Remidio Fundus on Phone: 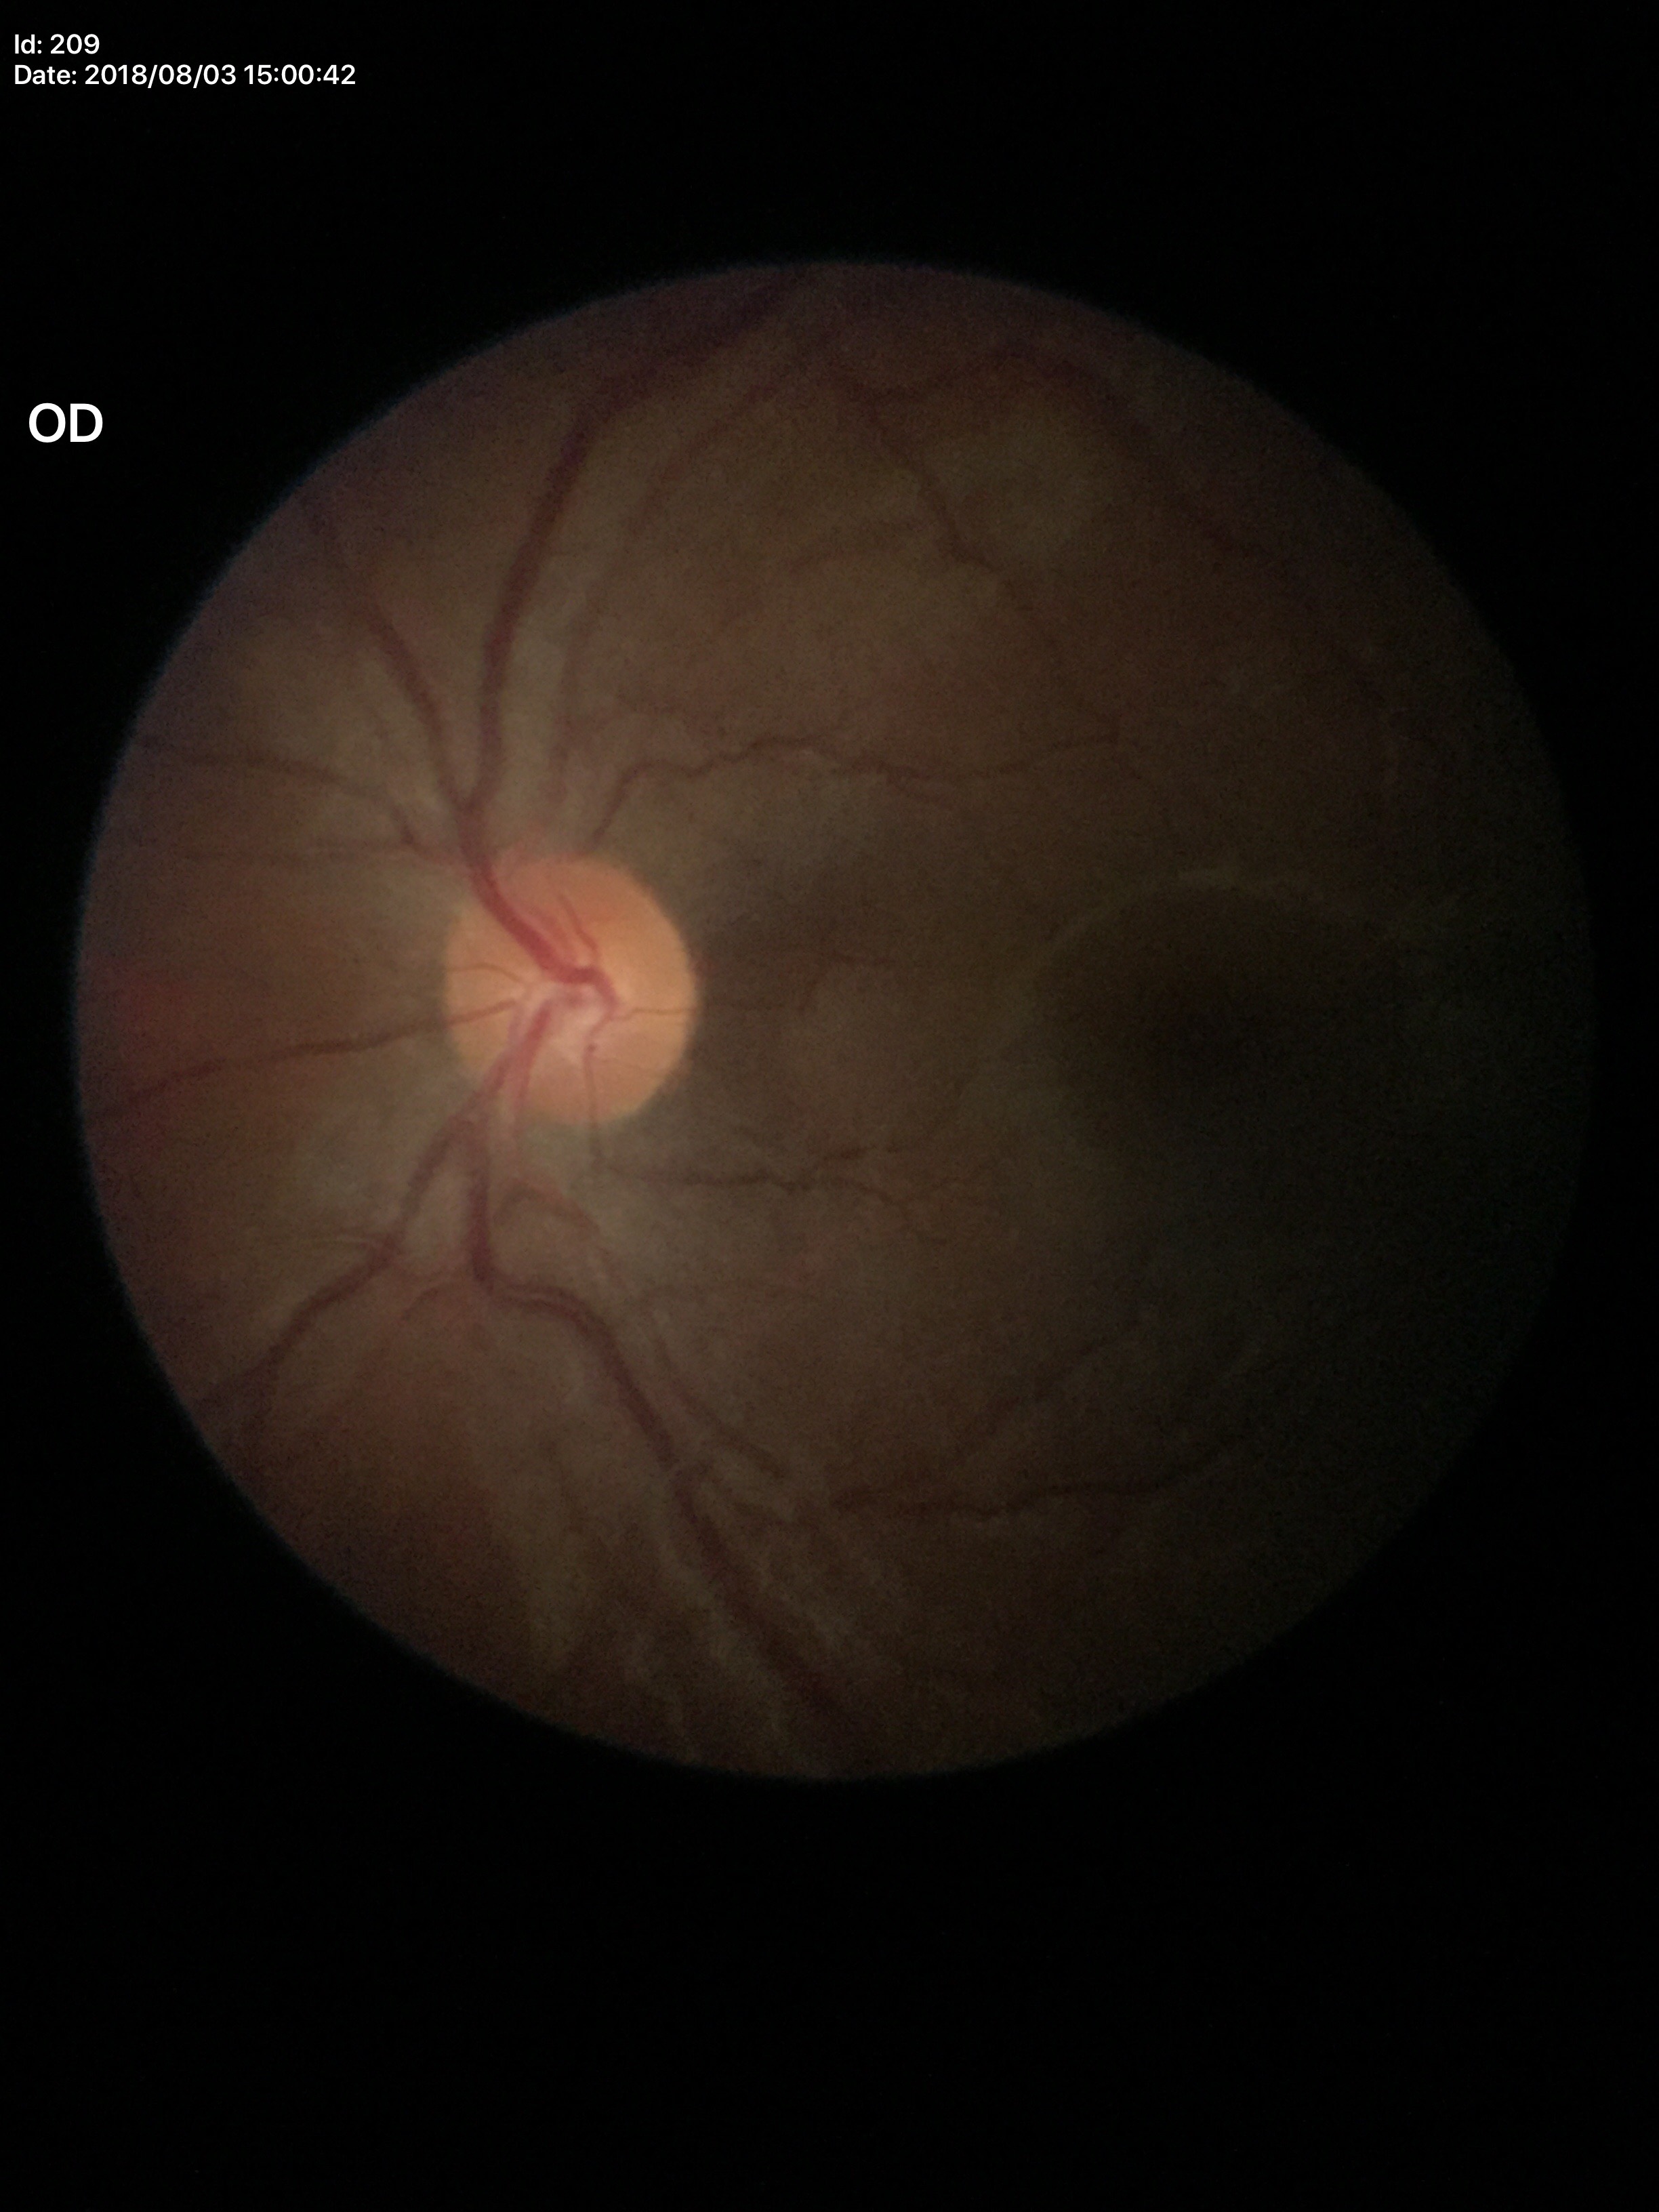

Glaucoma screening impression: no suspicious findings. Vertical CDR: 0.41. Horizontal CDR: 0.45.